1932 by 1916 pixels: 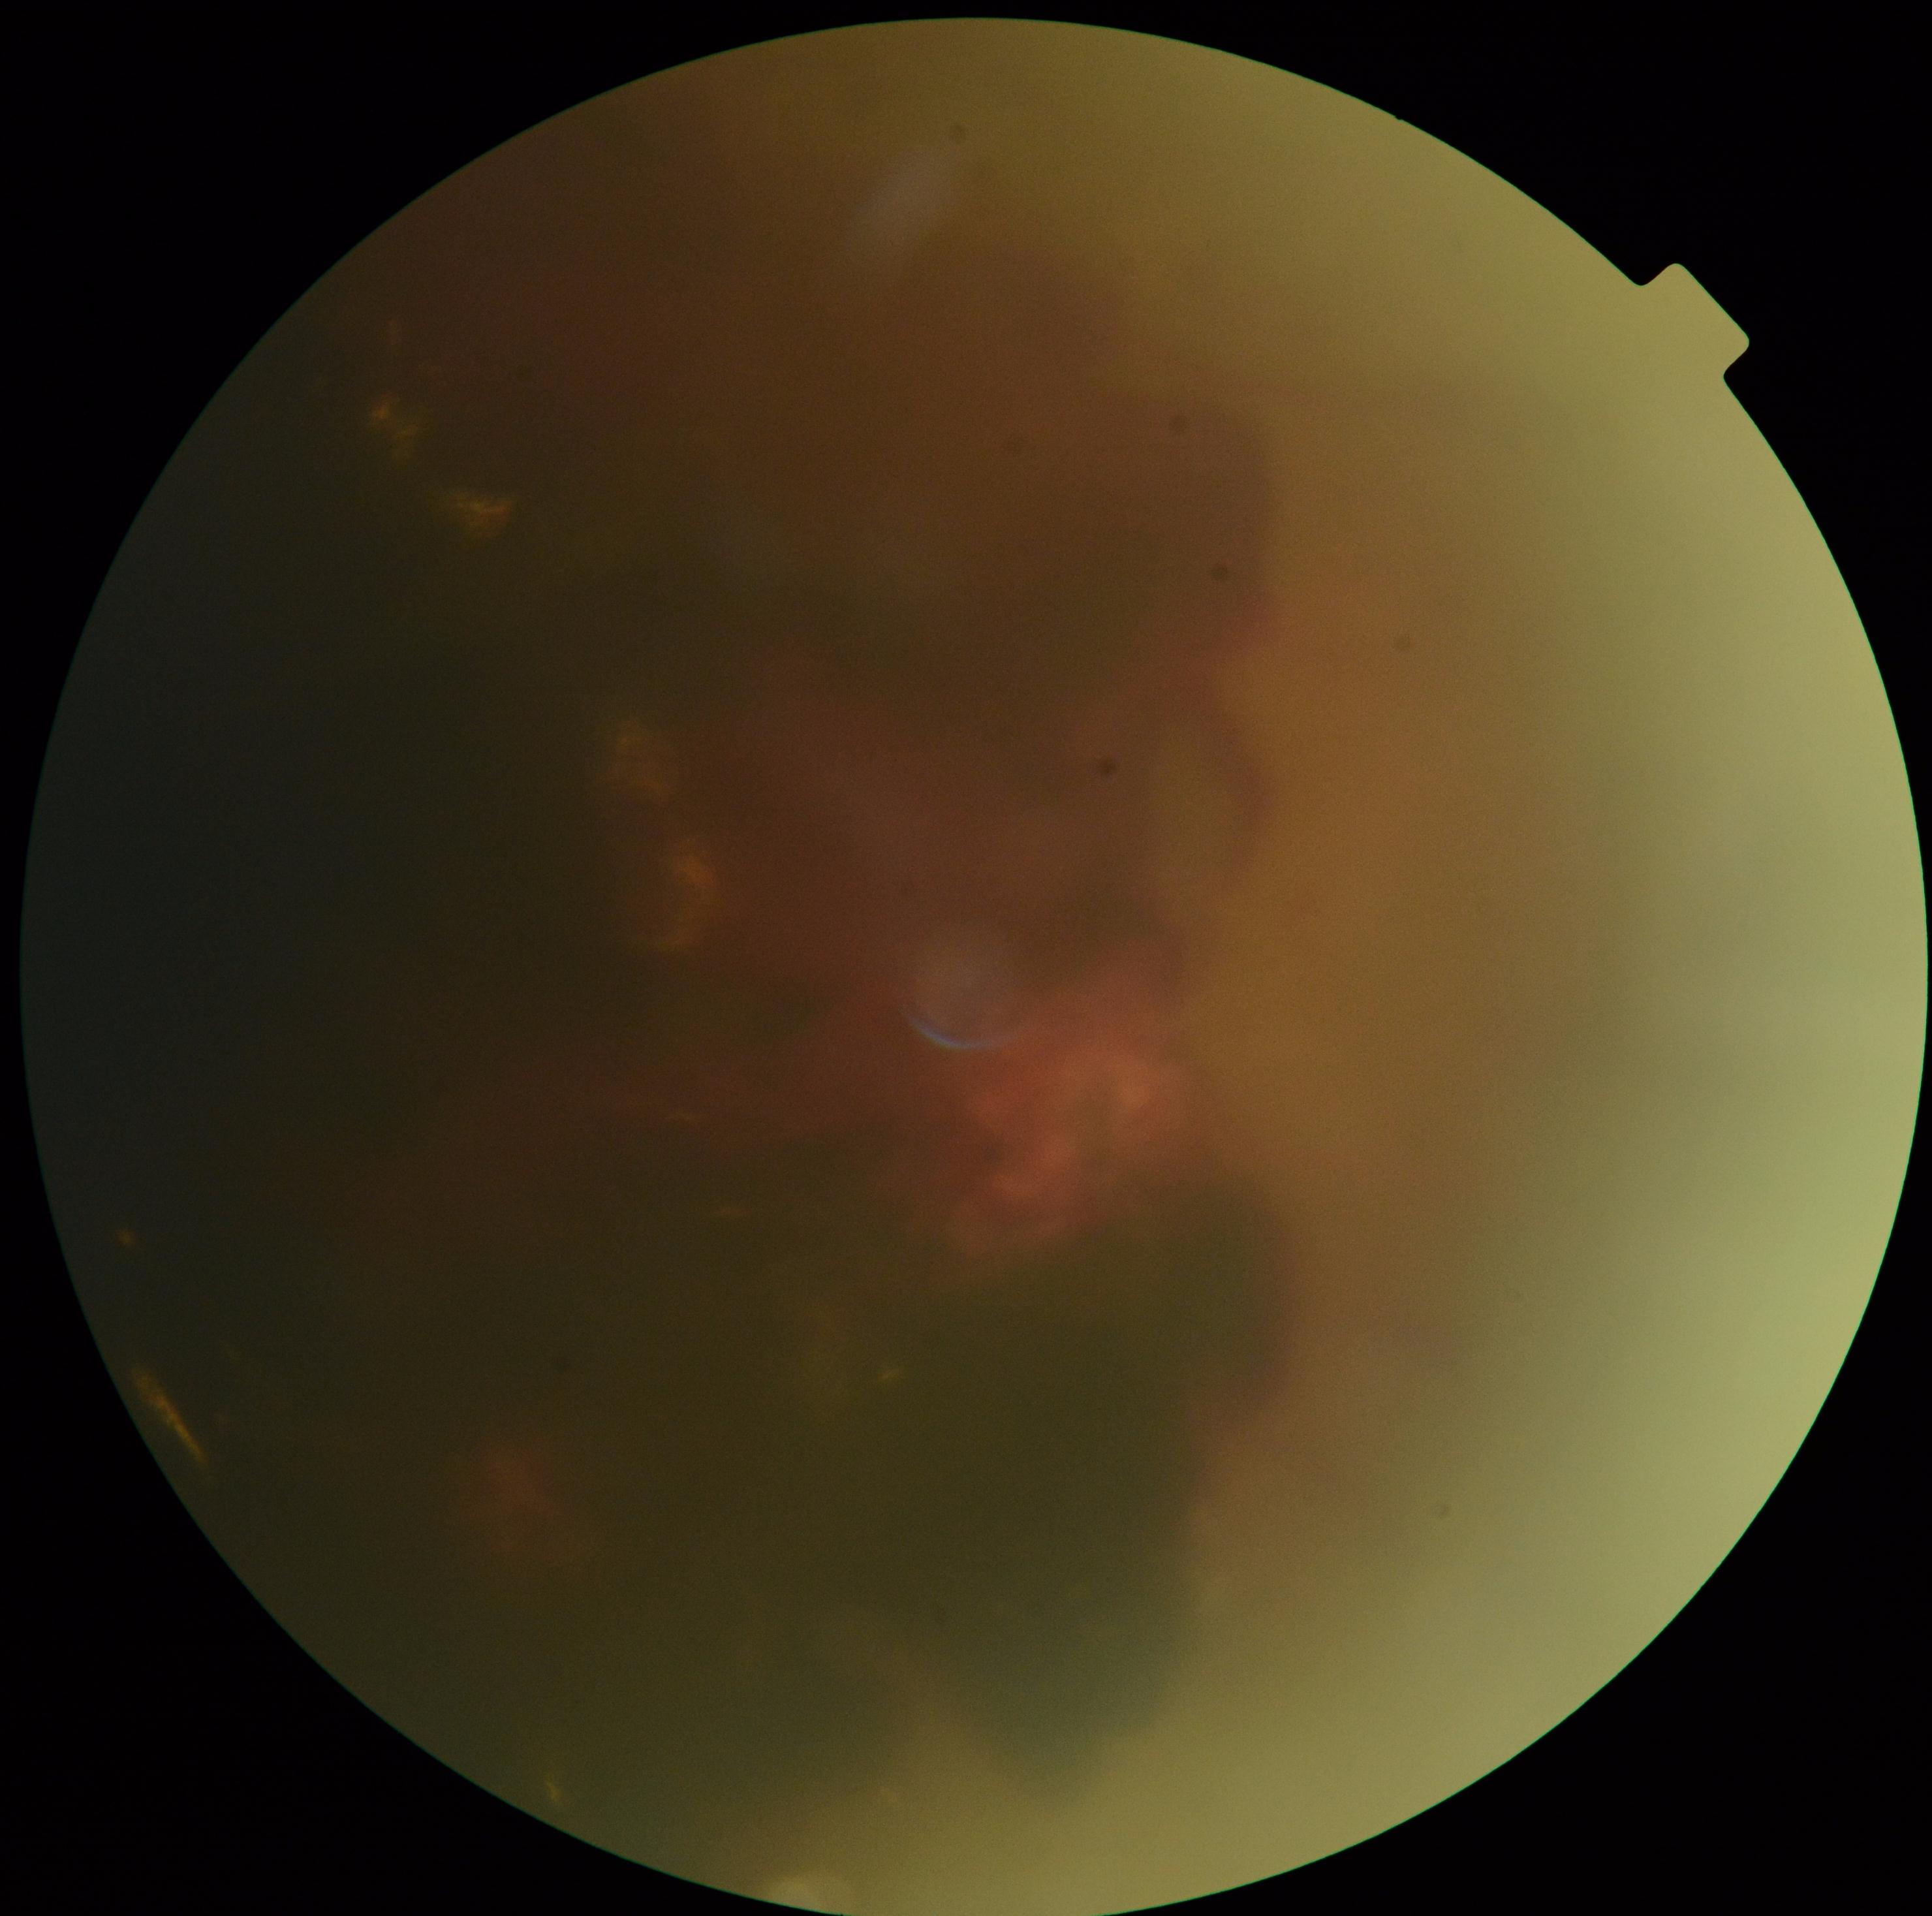
DR stage: 4 — neovascularization and/or vitreous/pre-retinal hemorrhage.